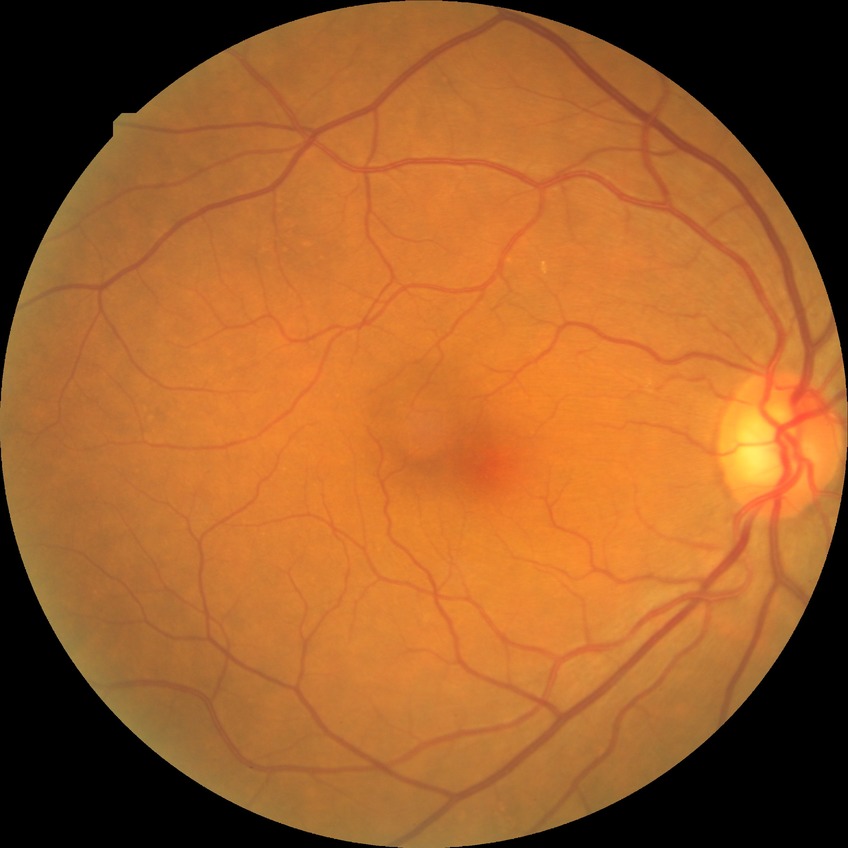

Diabetic retinopathy (DR): NDR (no diabetic retinopathy).